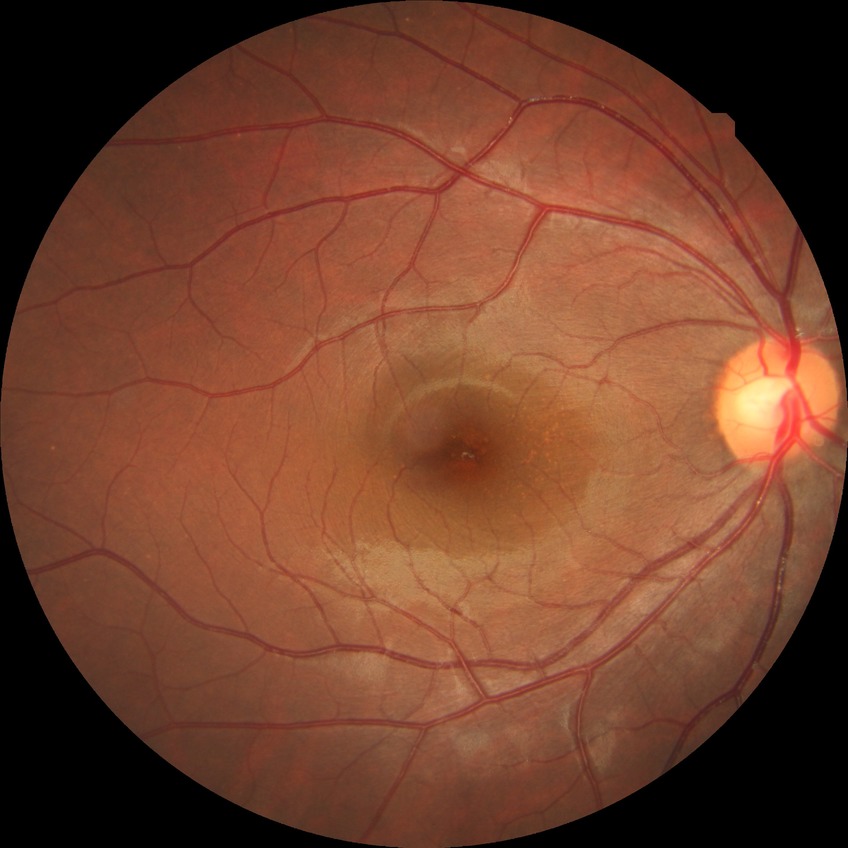 {"davis_grade": "no diabetic retinopathy"}